Intraocular pressure 18 mmHg by pneumatic tonometry; 2212 x 1661 pixels; axial length (AL): 23.56 mm; disc-centered field; non-mydriatic; 49-year-old patient
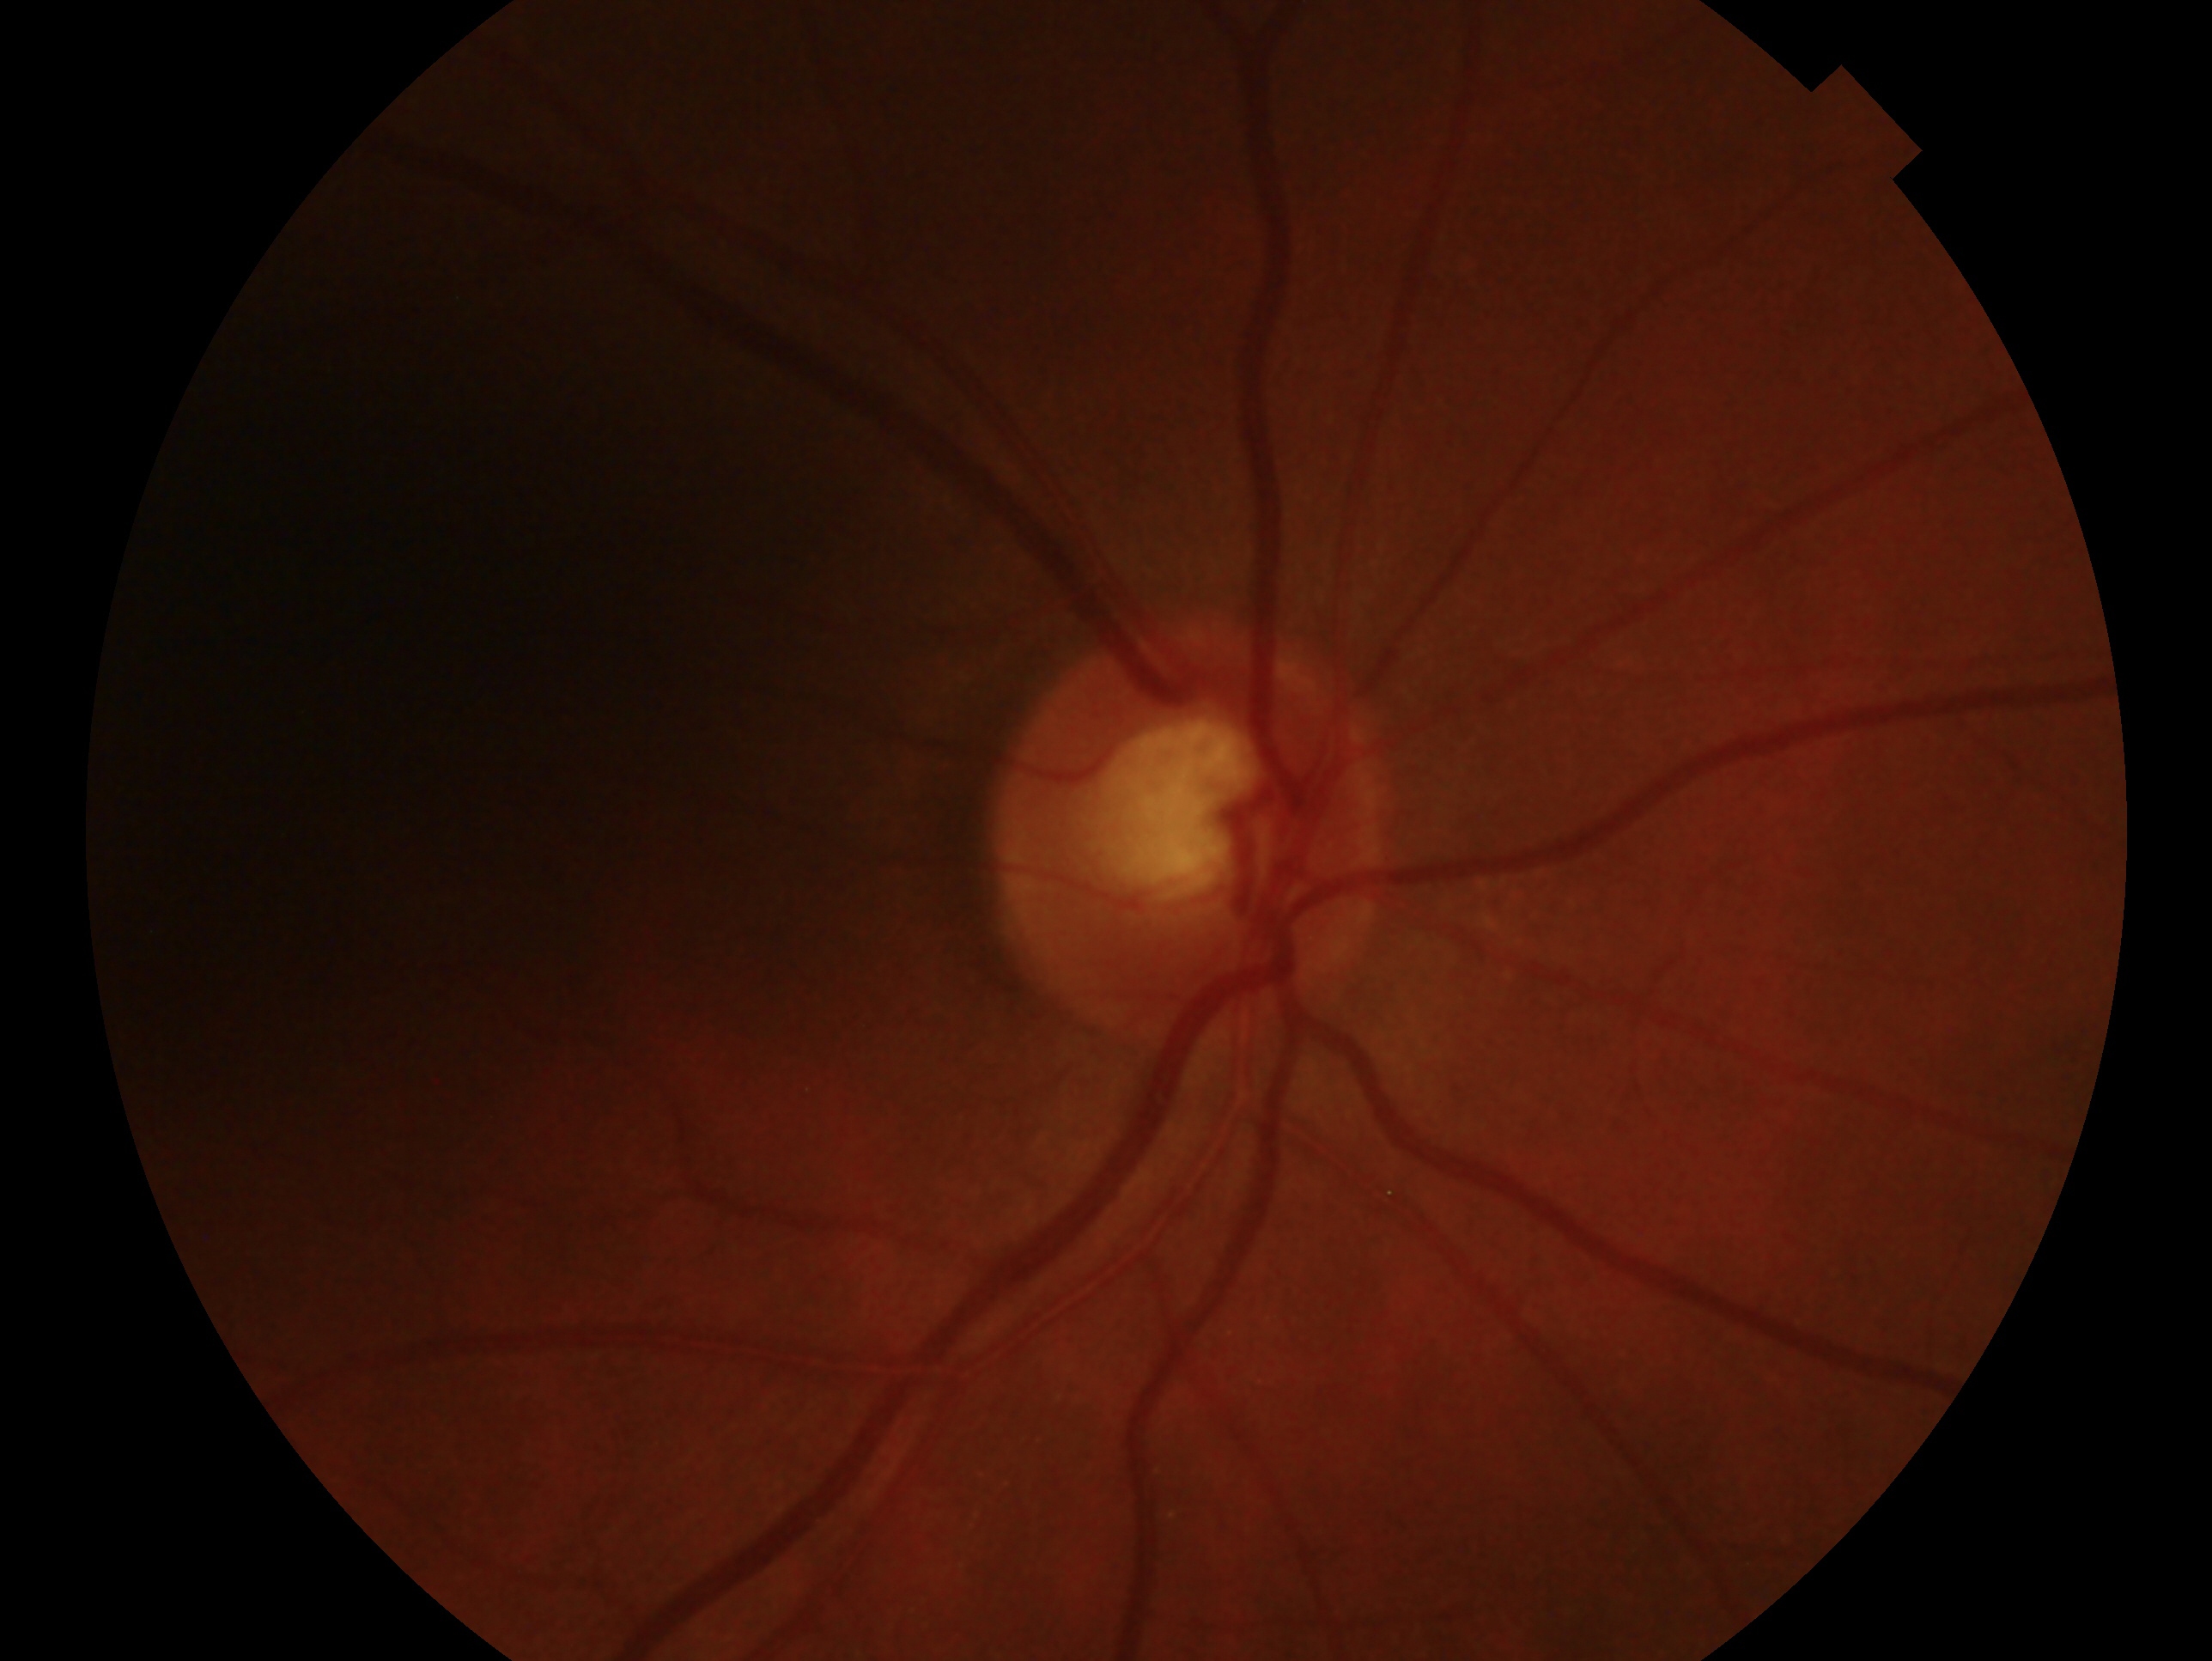

glaucoma diagnosis: no evidence of glaucoma — no clinical evidence of glaucoma in this eye | laterality: oculus dexter.